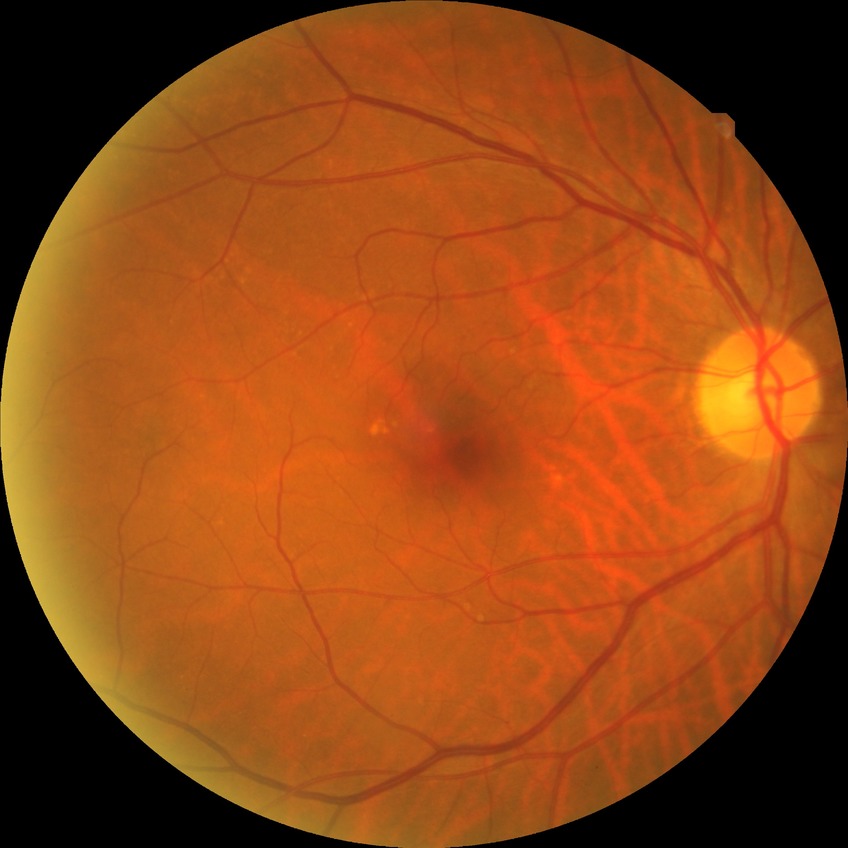

Assessment:
– diabetic retinopathy (DR) — NDR (no diabetic retinopathy)